CFP
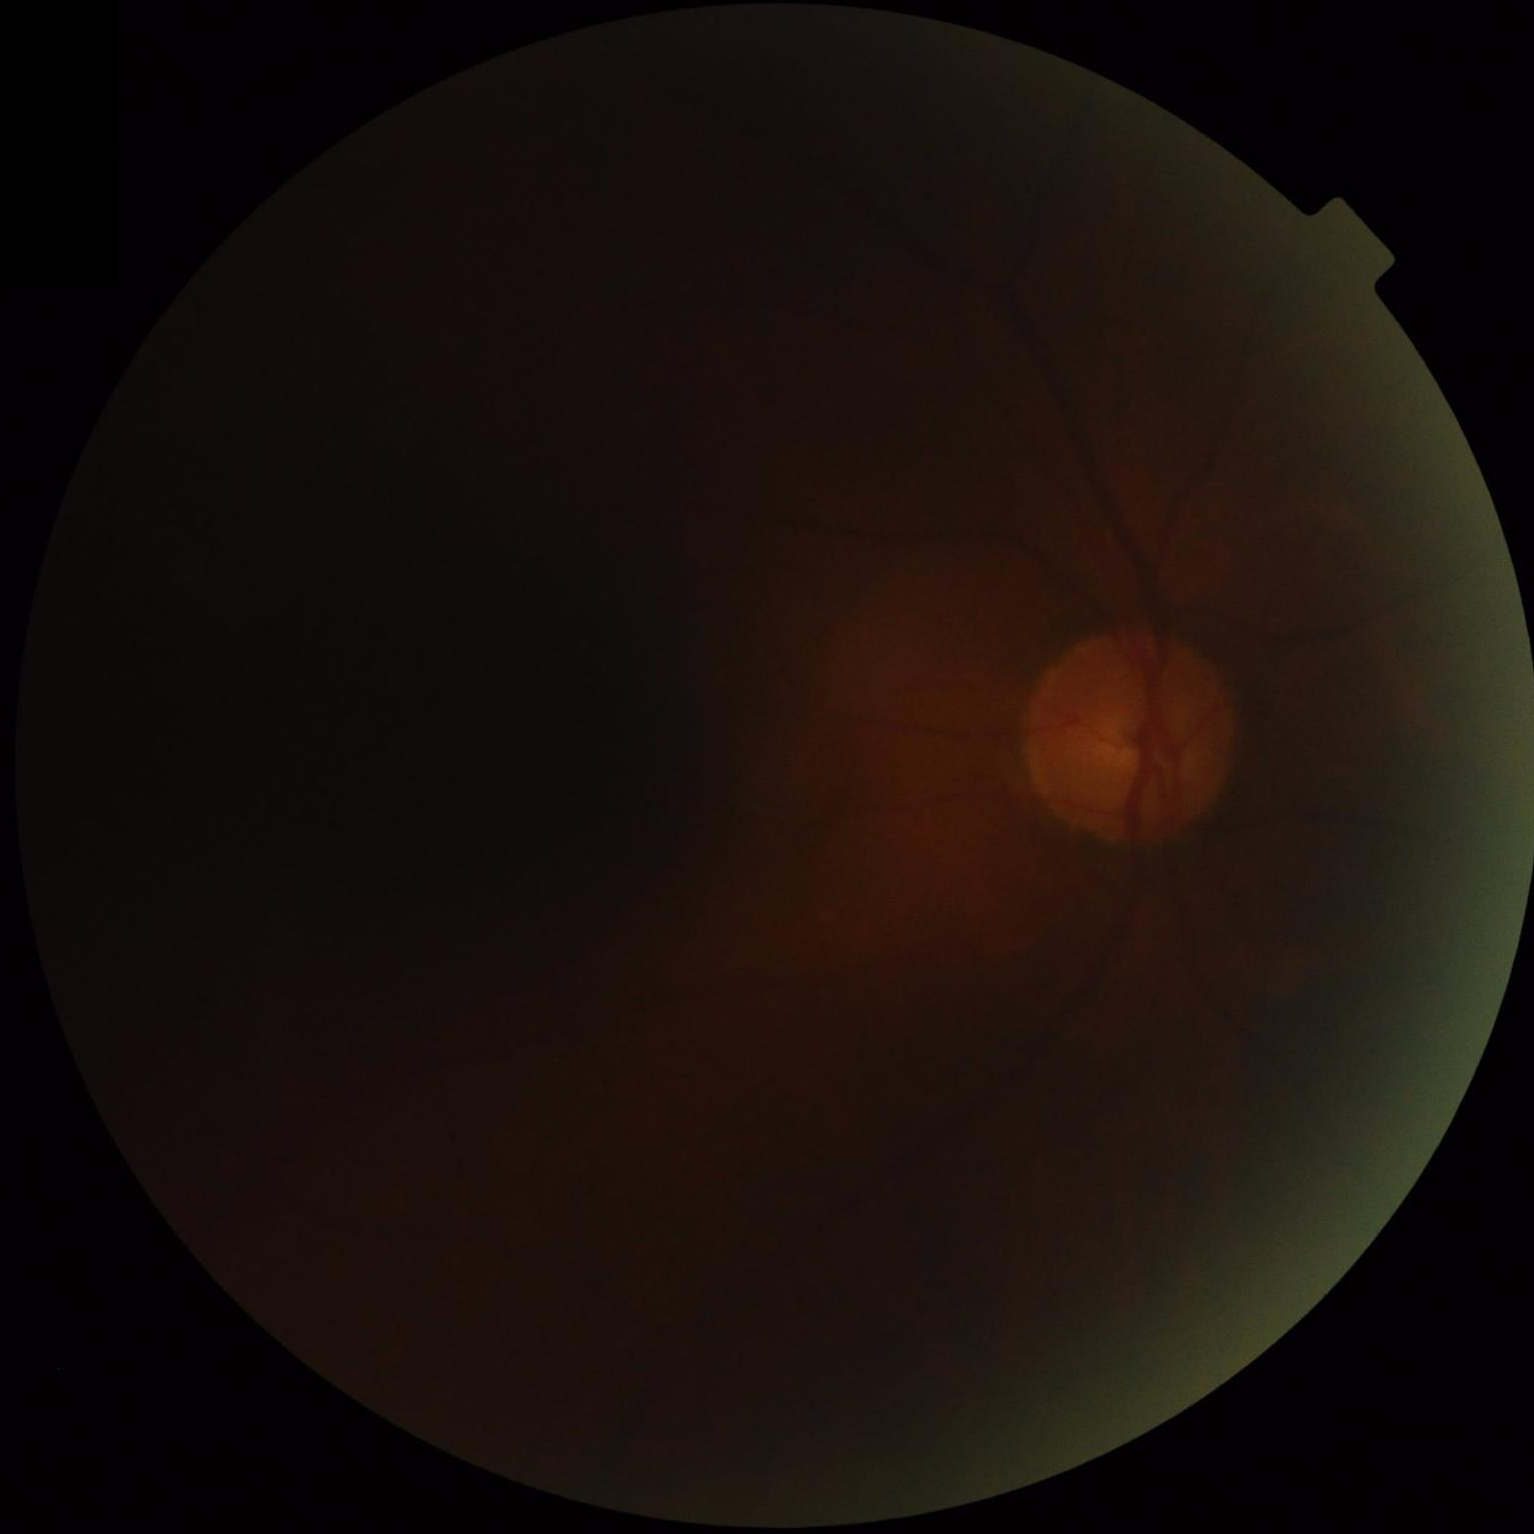

Overall: poor, ungradable | Sharpness: reduced sharpness with visible blur | Illumination/color: inadequate, with uneven exposure or color distortion | Contrast: poor dynamic range.